Infant wide-field retinal image; 640x480px.
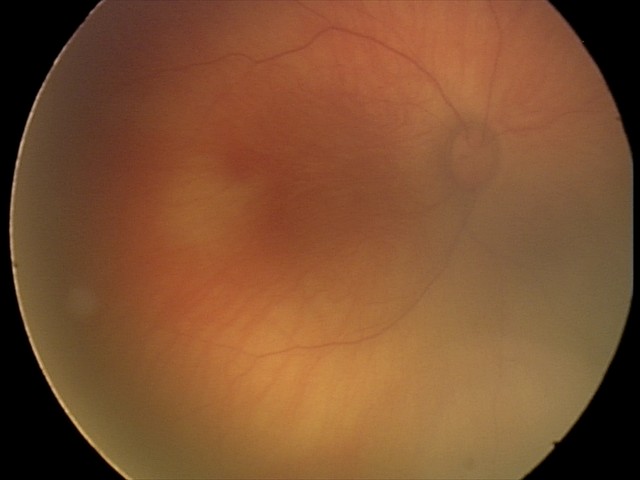

Examination diagnosed as retinal hemorrhages.